1924x1556px; 50° FOV; color fundus photograph.
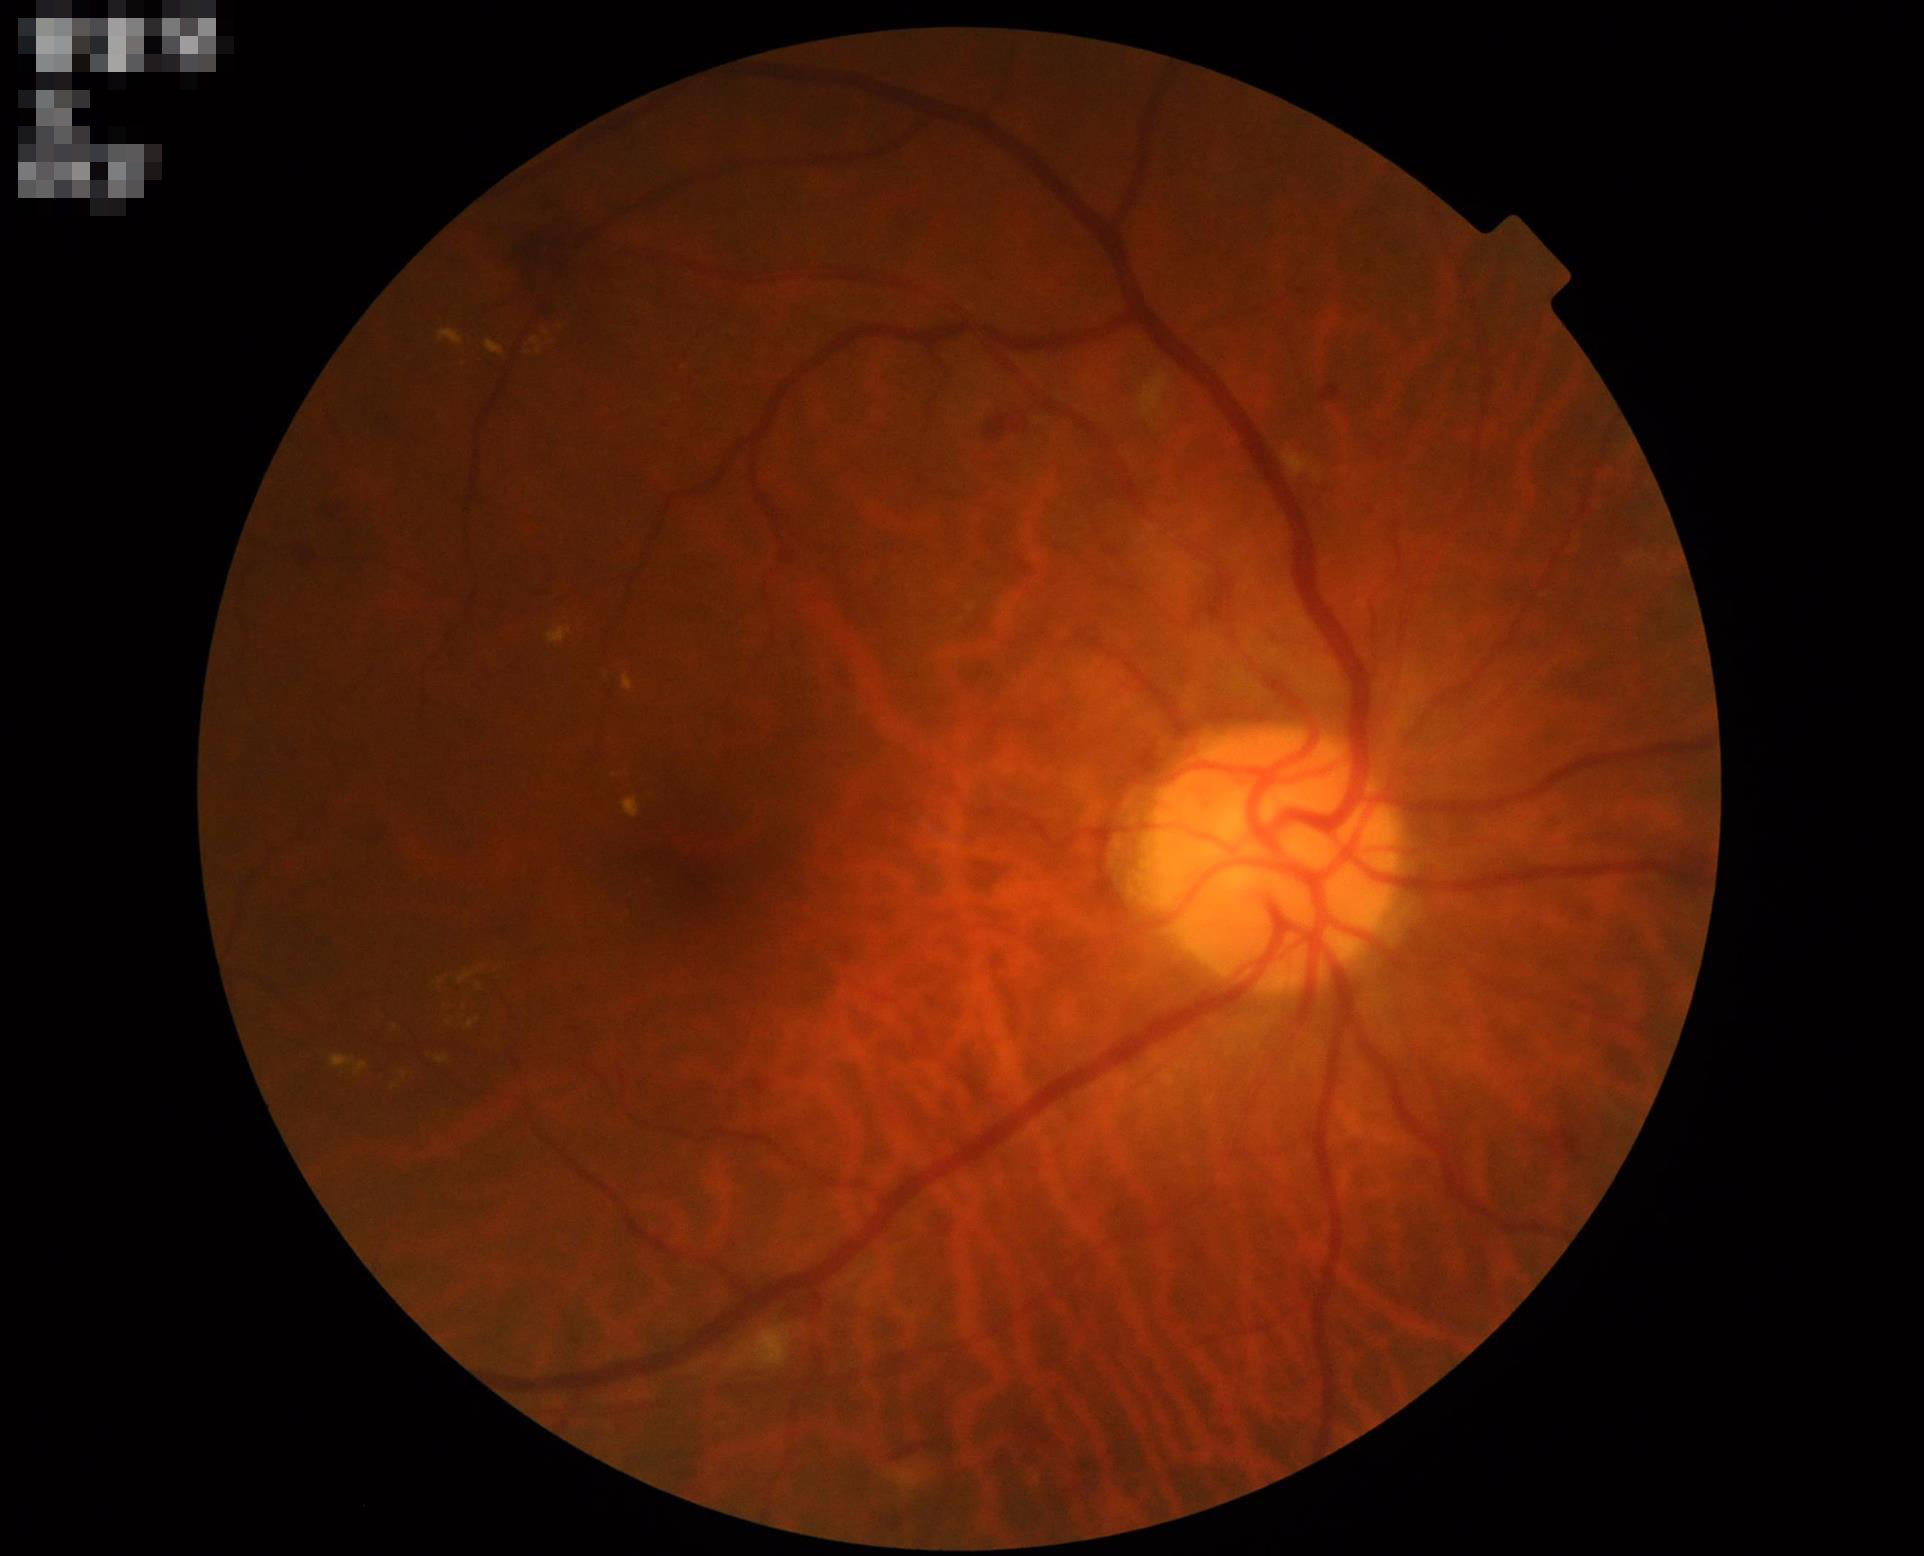

Contrast = good dynamic range
Overall image quality = good and suitable for diagnostic use
Focus = optic disc, vessels, and background in focus
Illumination = good illumination and color balance